45-degree field of view:
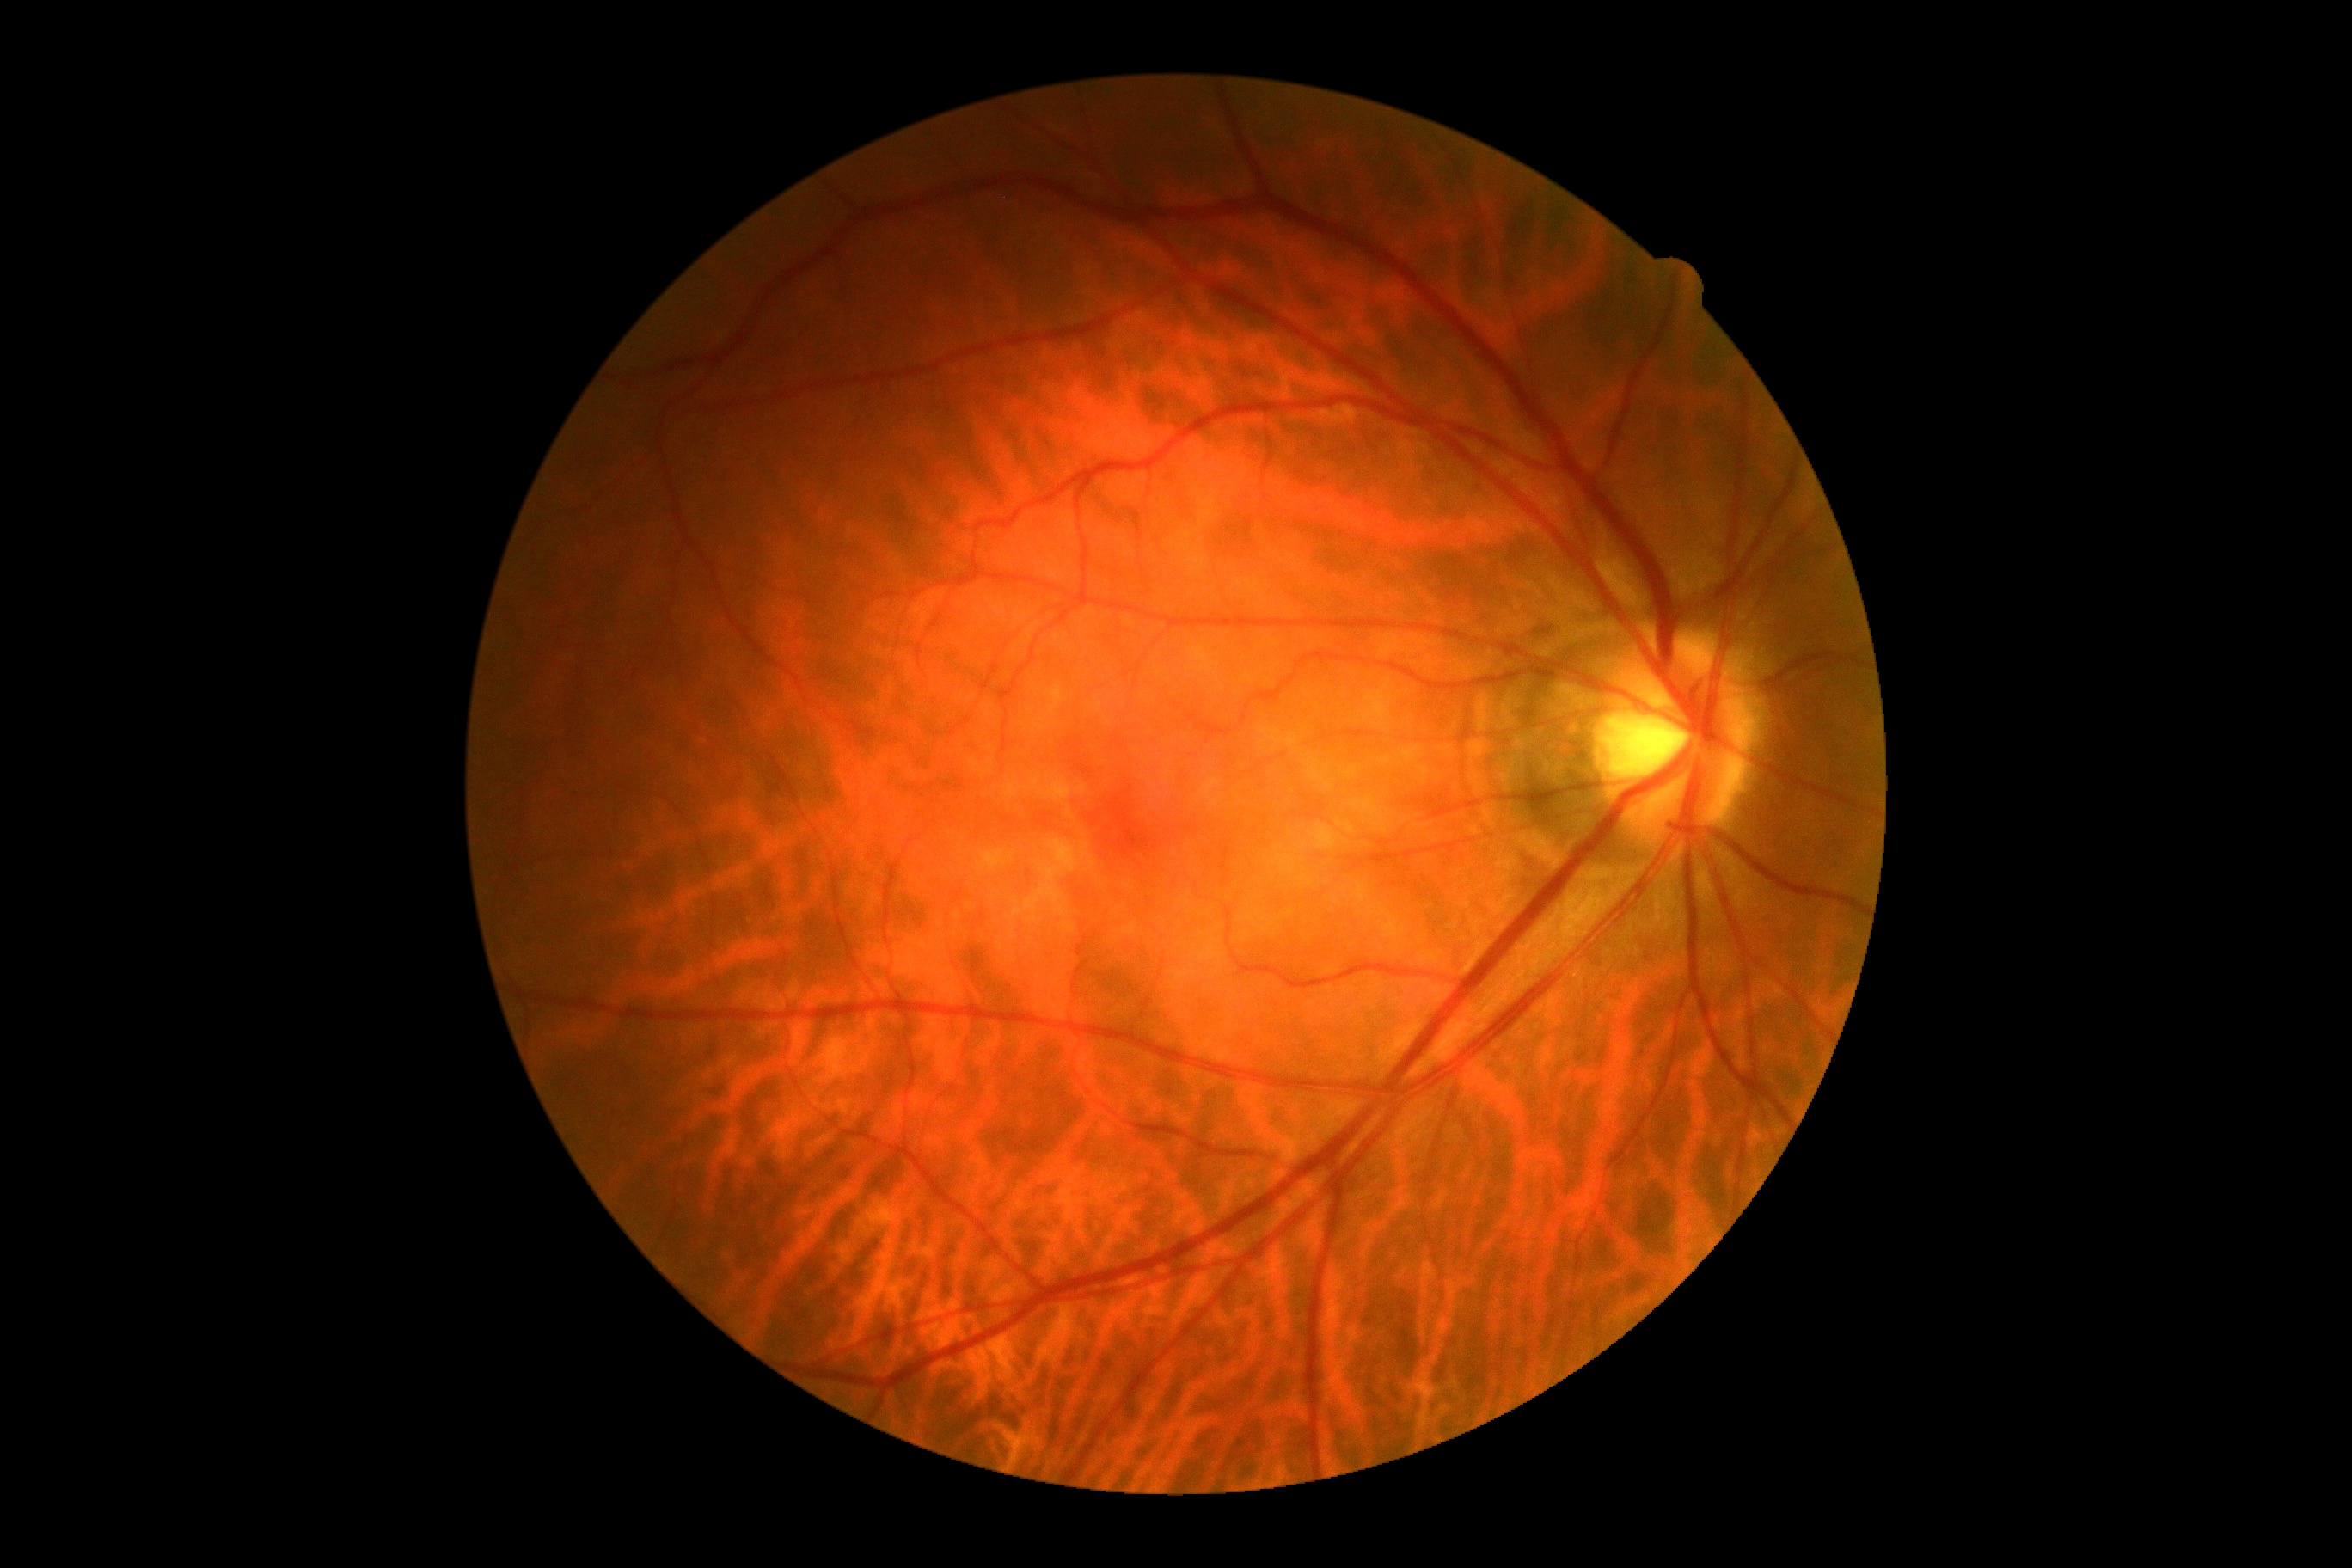 diabetic retinopathy (DR): grade 0 (no apparent retinopathy)
DR impression: no DR findings